1440x1080; wide-field fundus image from infant ROP screening; acquired on the Natus RetCam Envision:
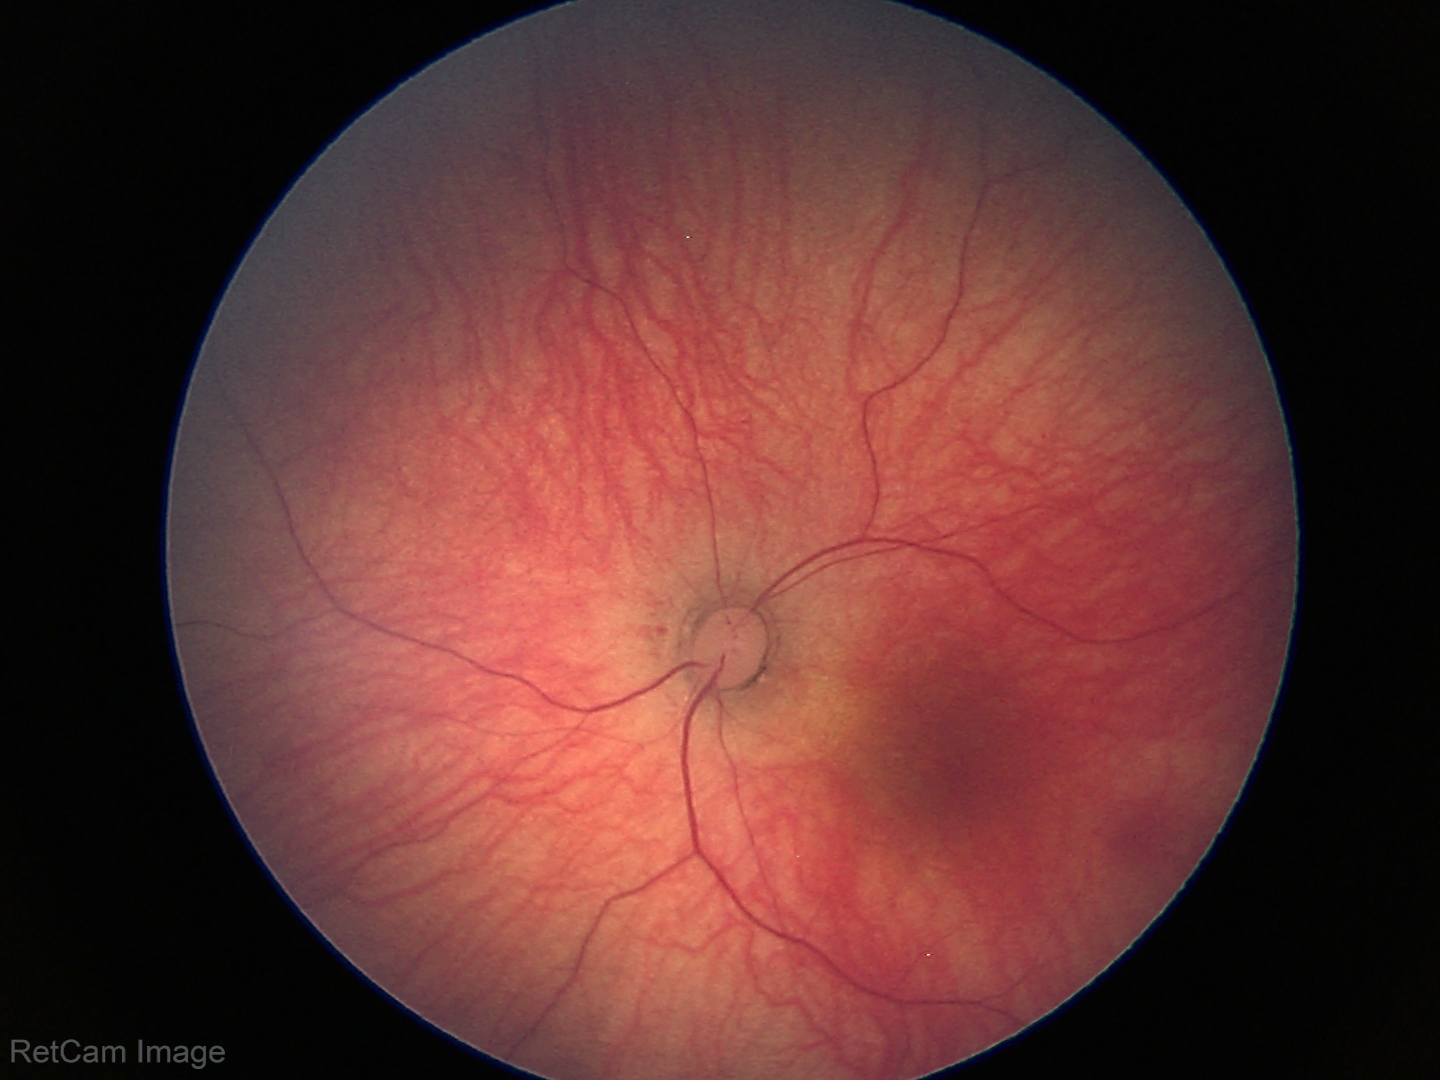

Screening: physiological appearance with no retinal pathology.